Diabetic retinopathy graded by the modified Davis classification. No pharmacologic dilation. Posterior pole photograph
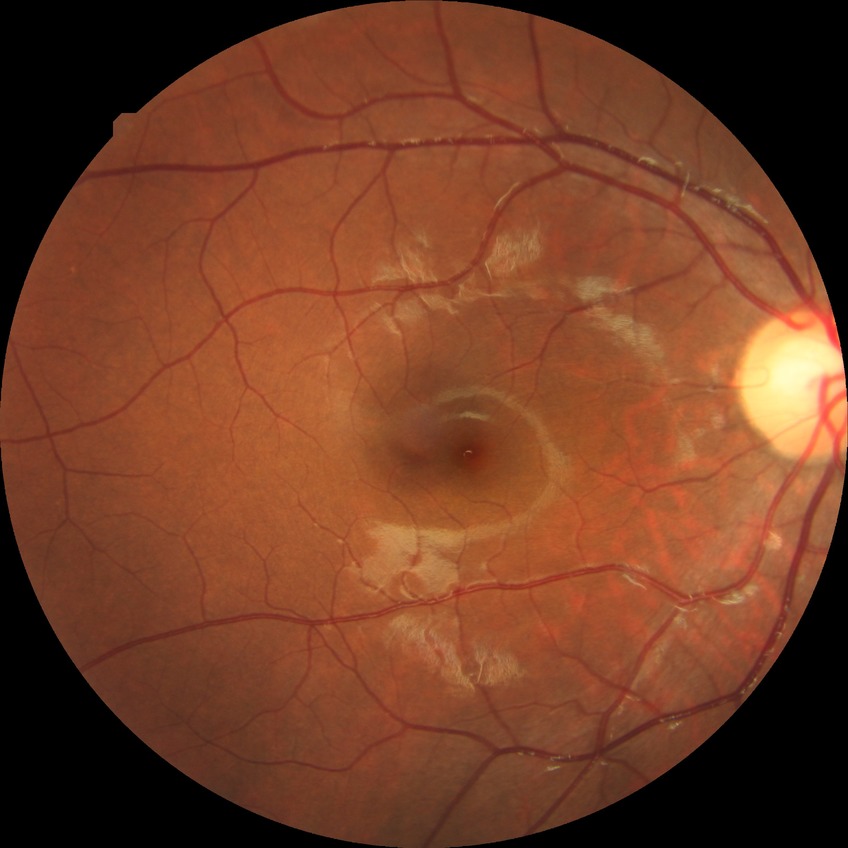
* diabetic retinopathy (DR) — no diabetic retinopathy (NDR)